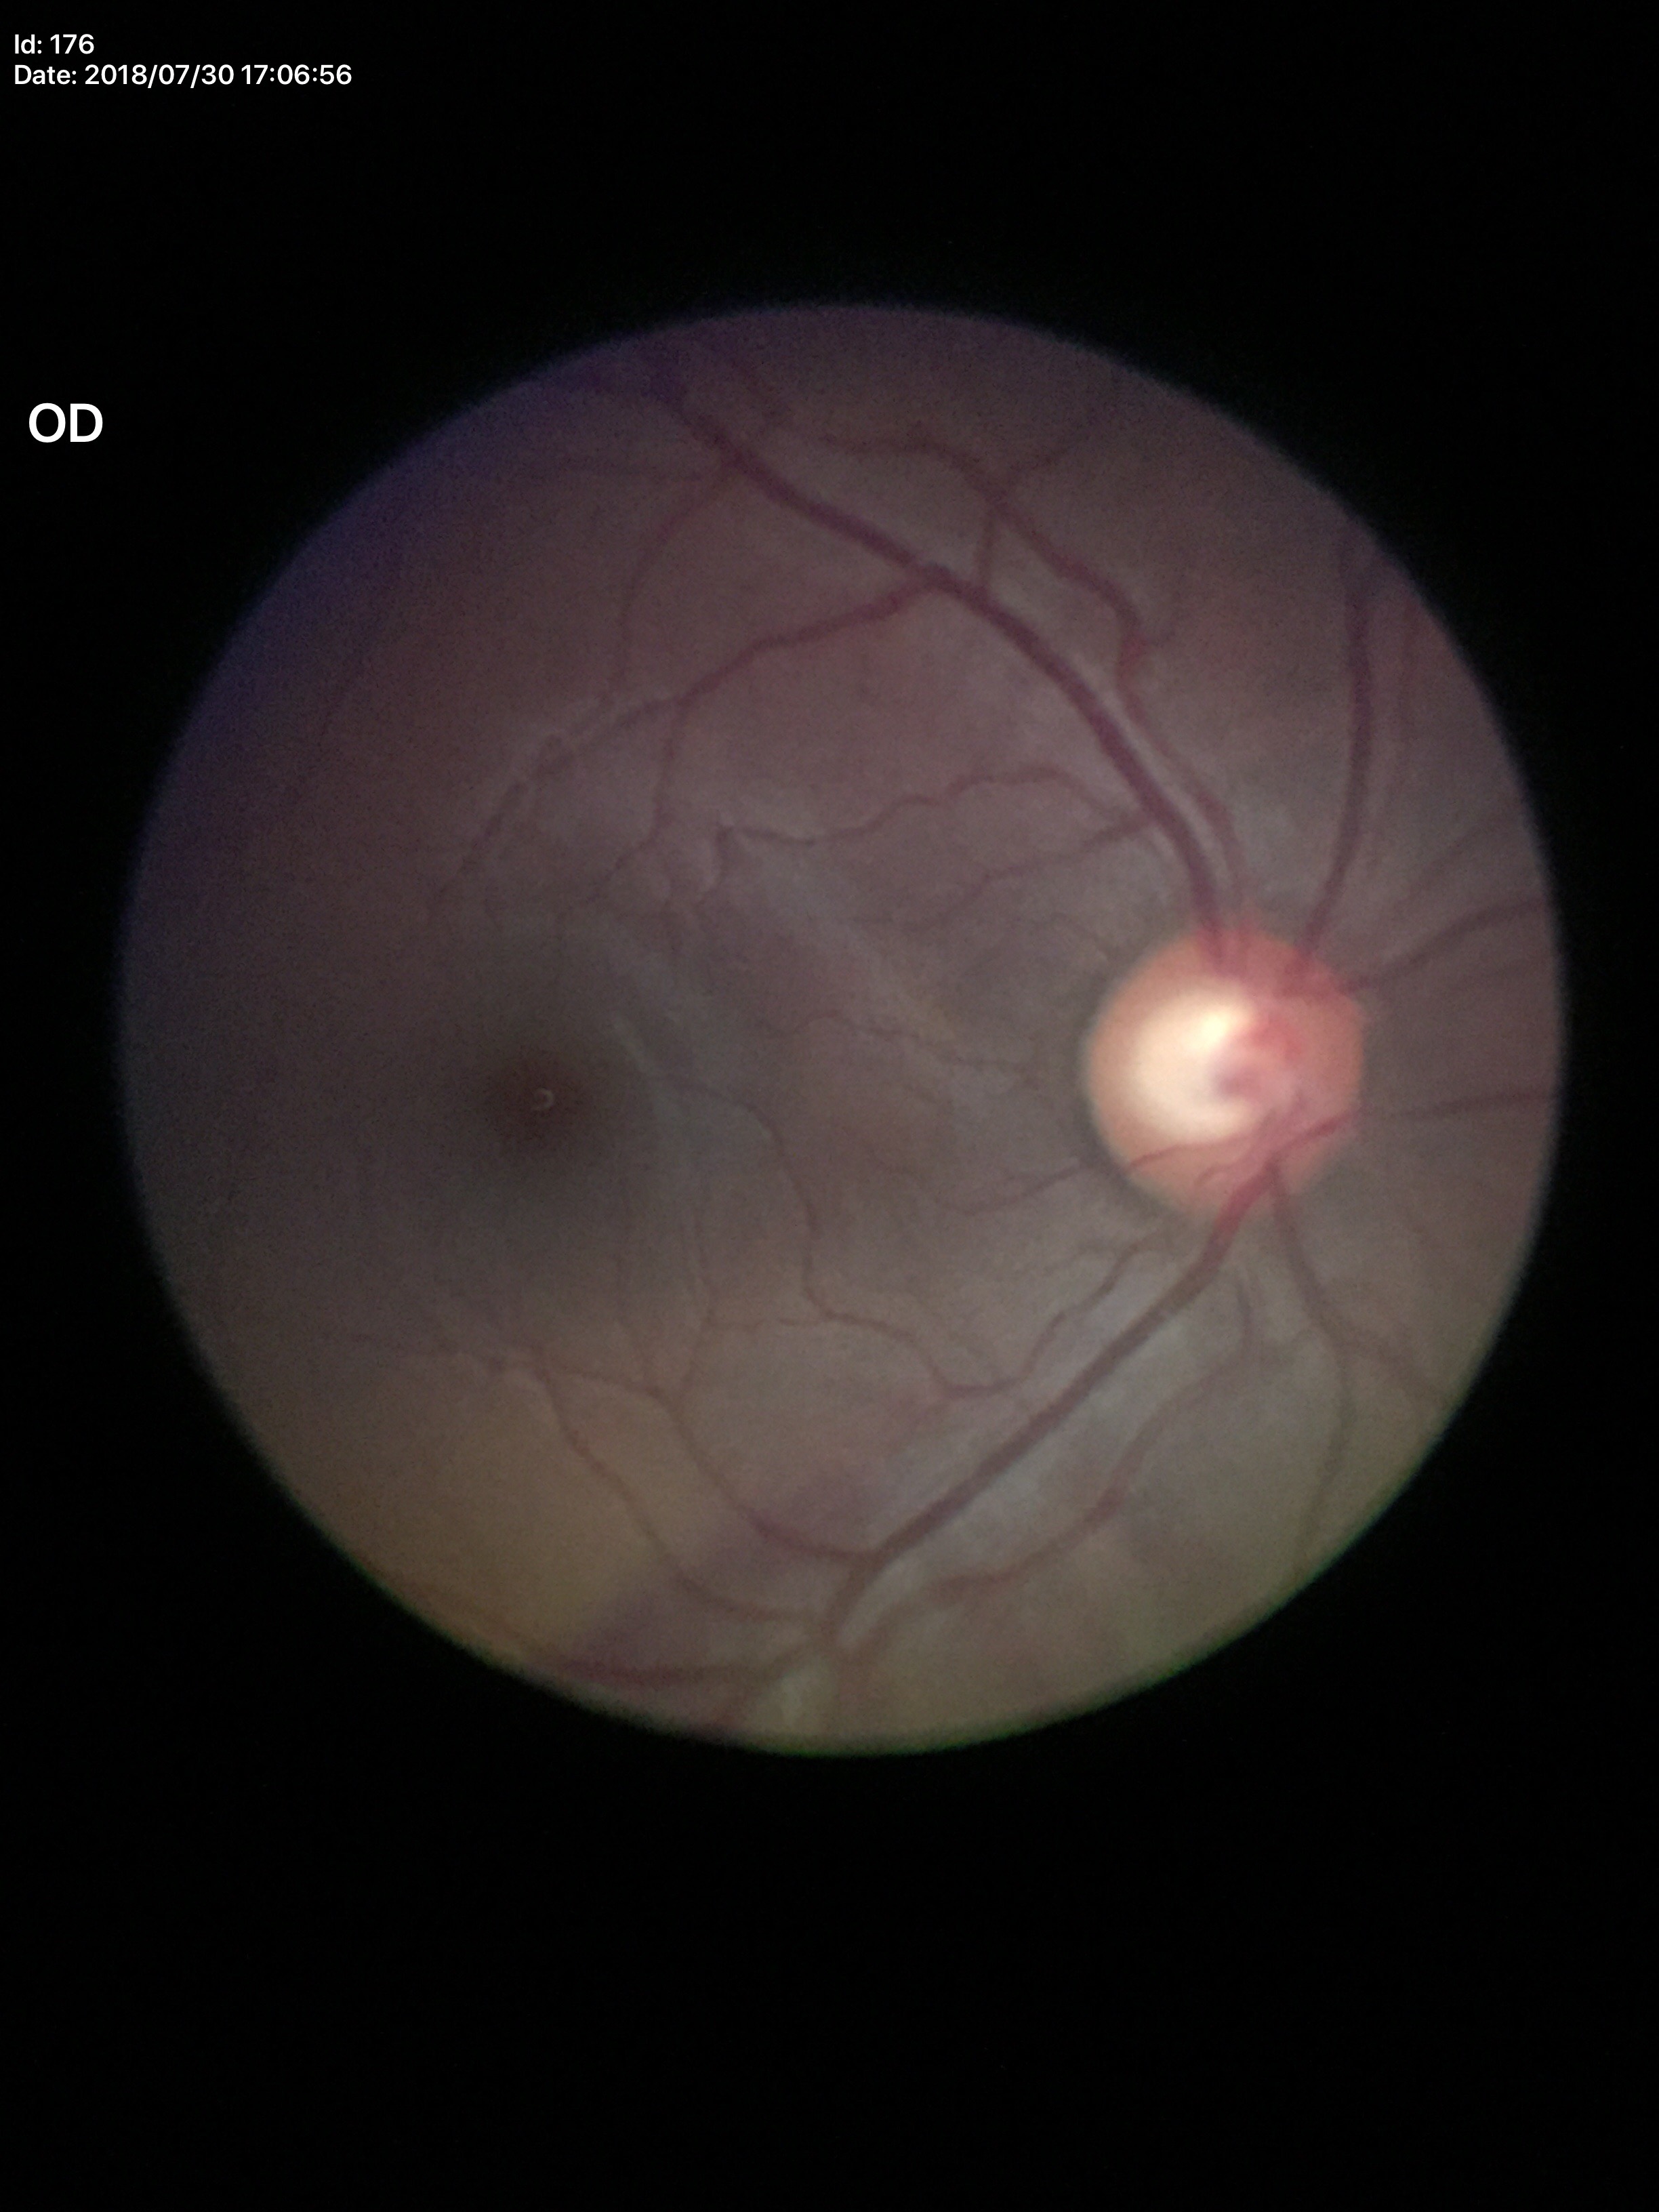
Glaucoma impression: suspicious (4/5 graders called glaucoma suspect).
VCDR of 0.63.